Retinal fundus photograph · 45° field of view:
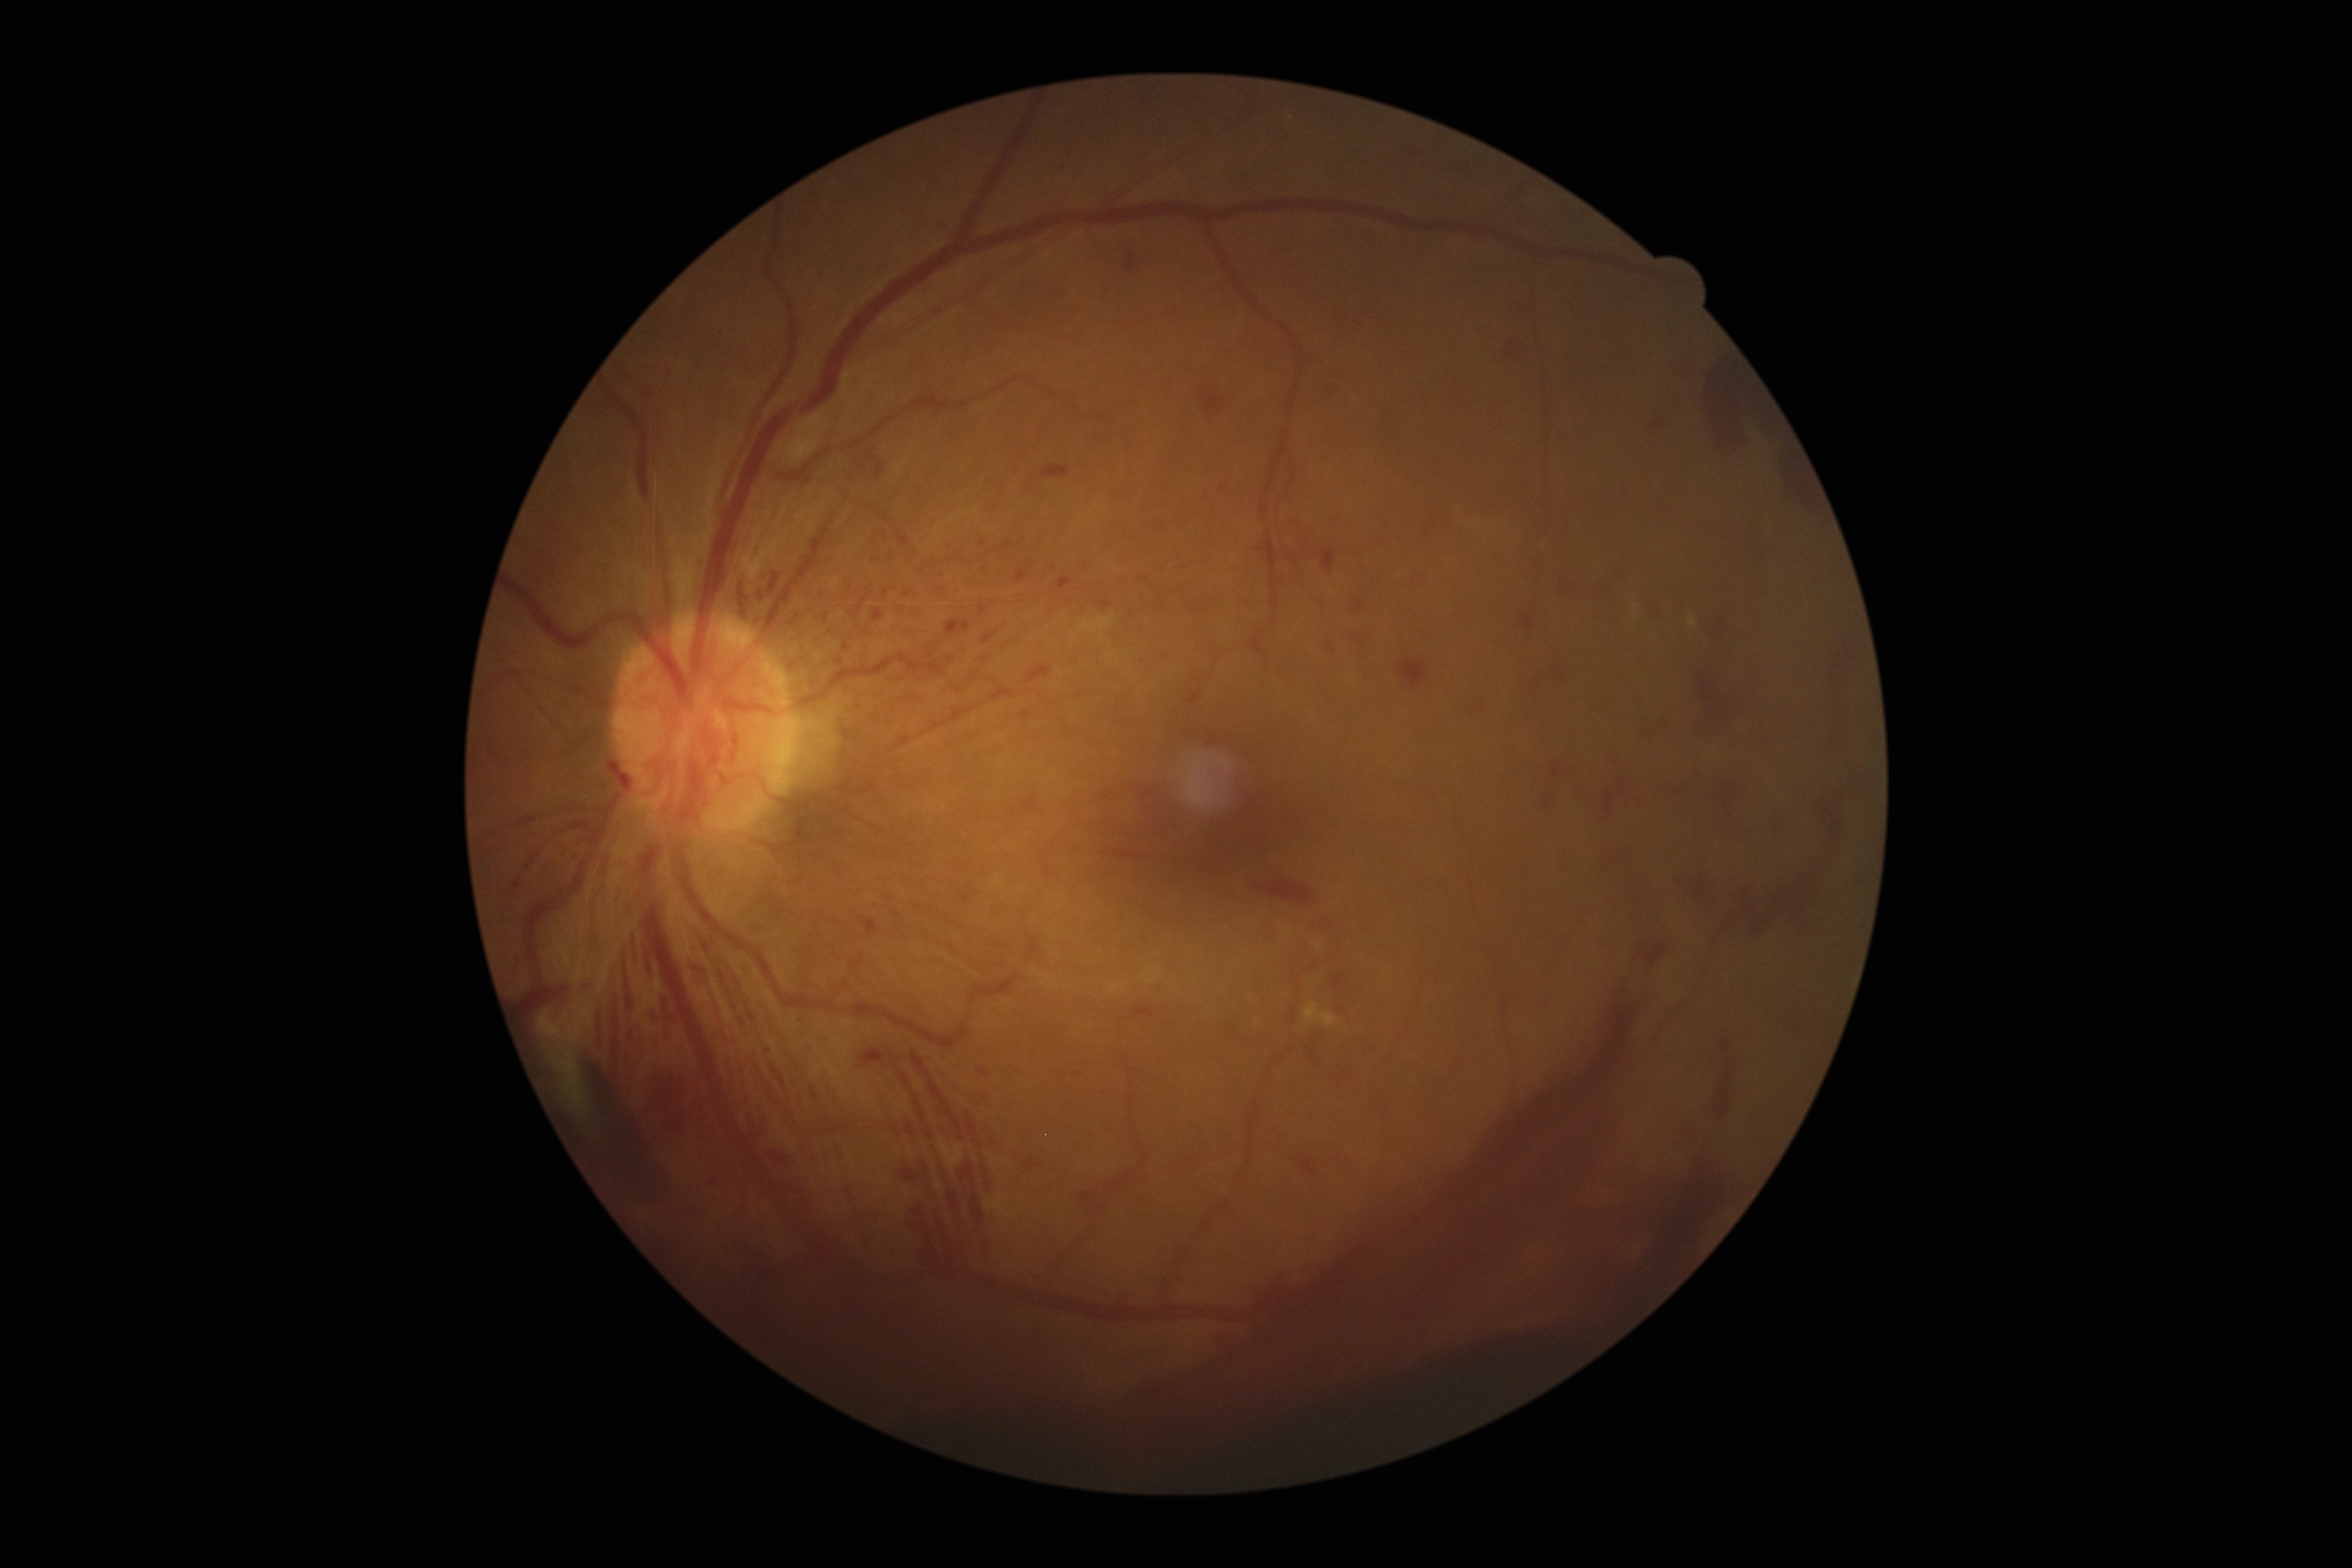

diabetic retinopathy (DR): 4/4 | DR class: proliferative diabetic retinopathy.